848x848. NIDEK AFC-230. Fundus photo.
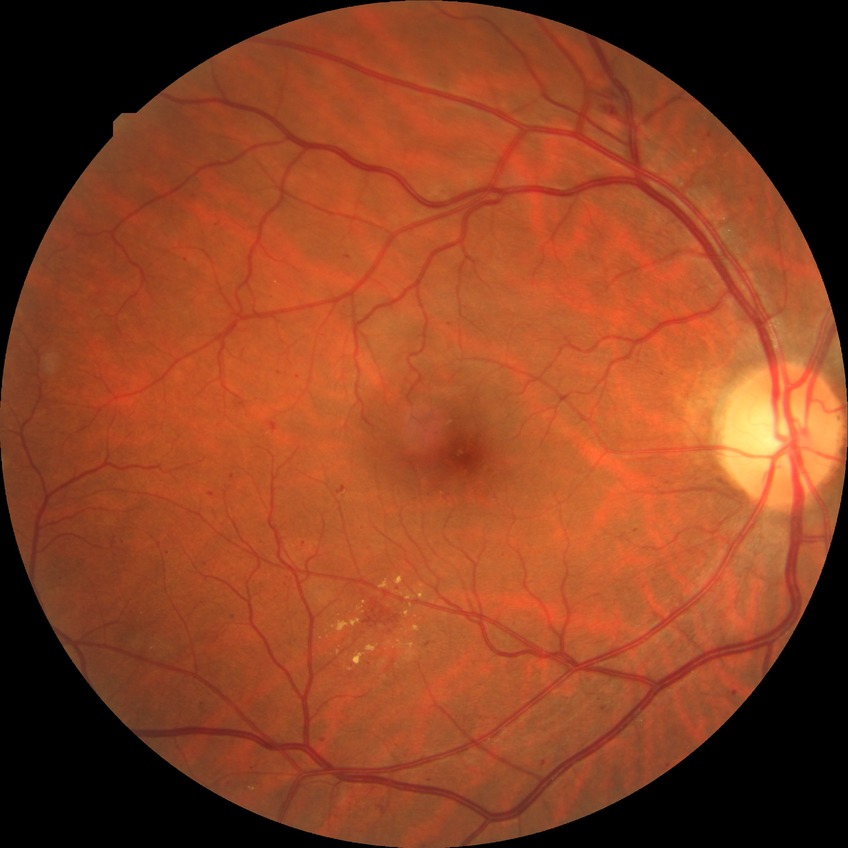
diabetic retinopathy severity: pre-proliferative diabetic retinopathy; DR class: non-proliferative diabetic retinopathy.